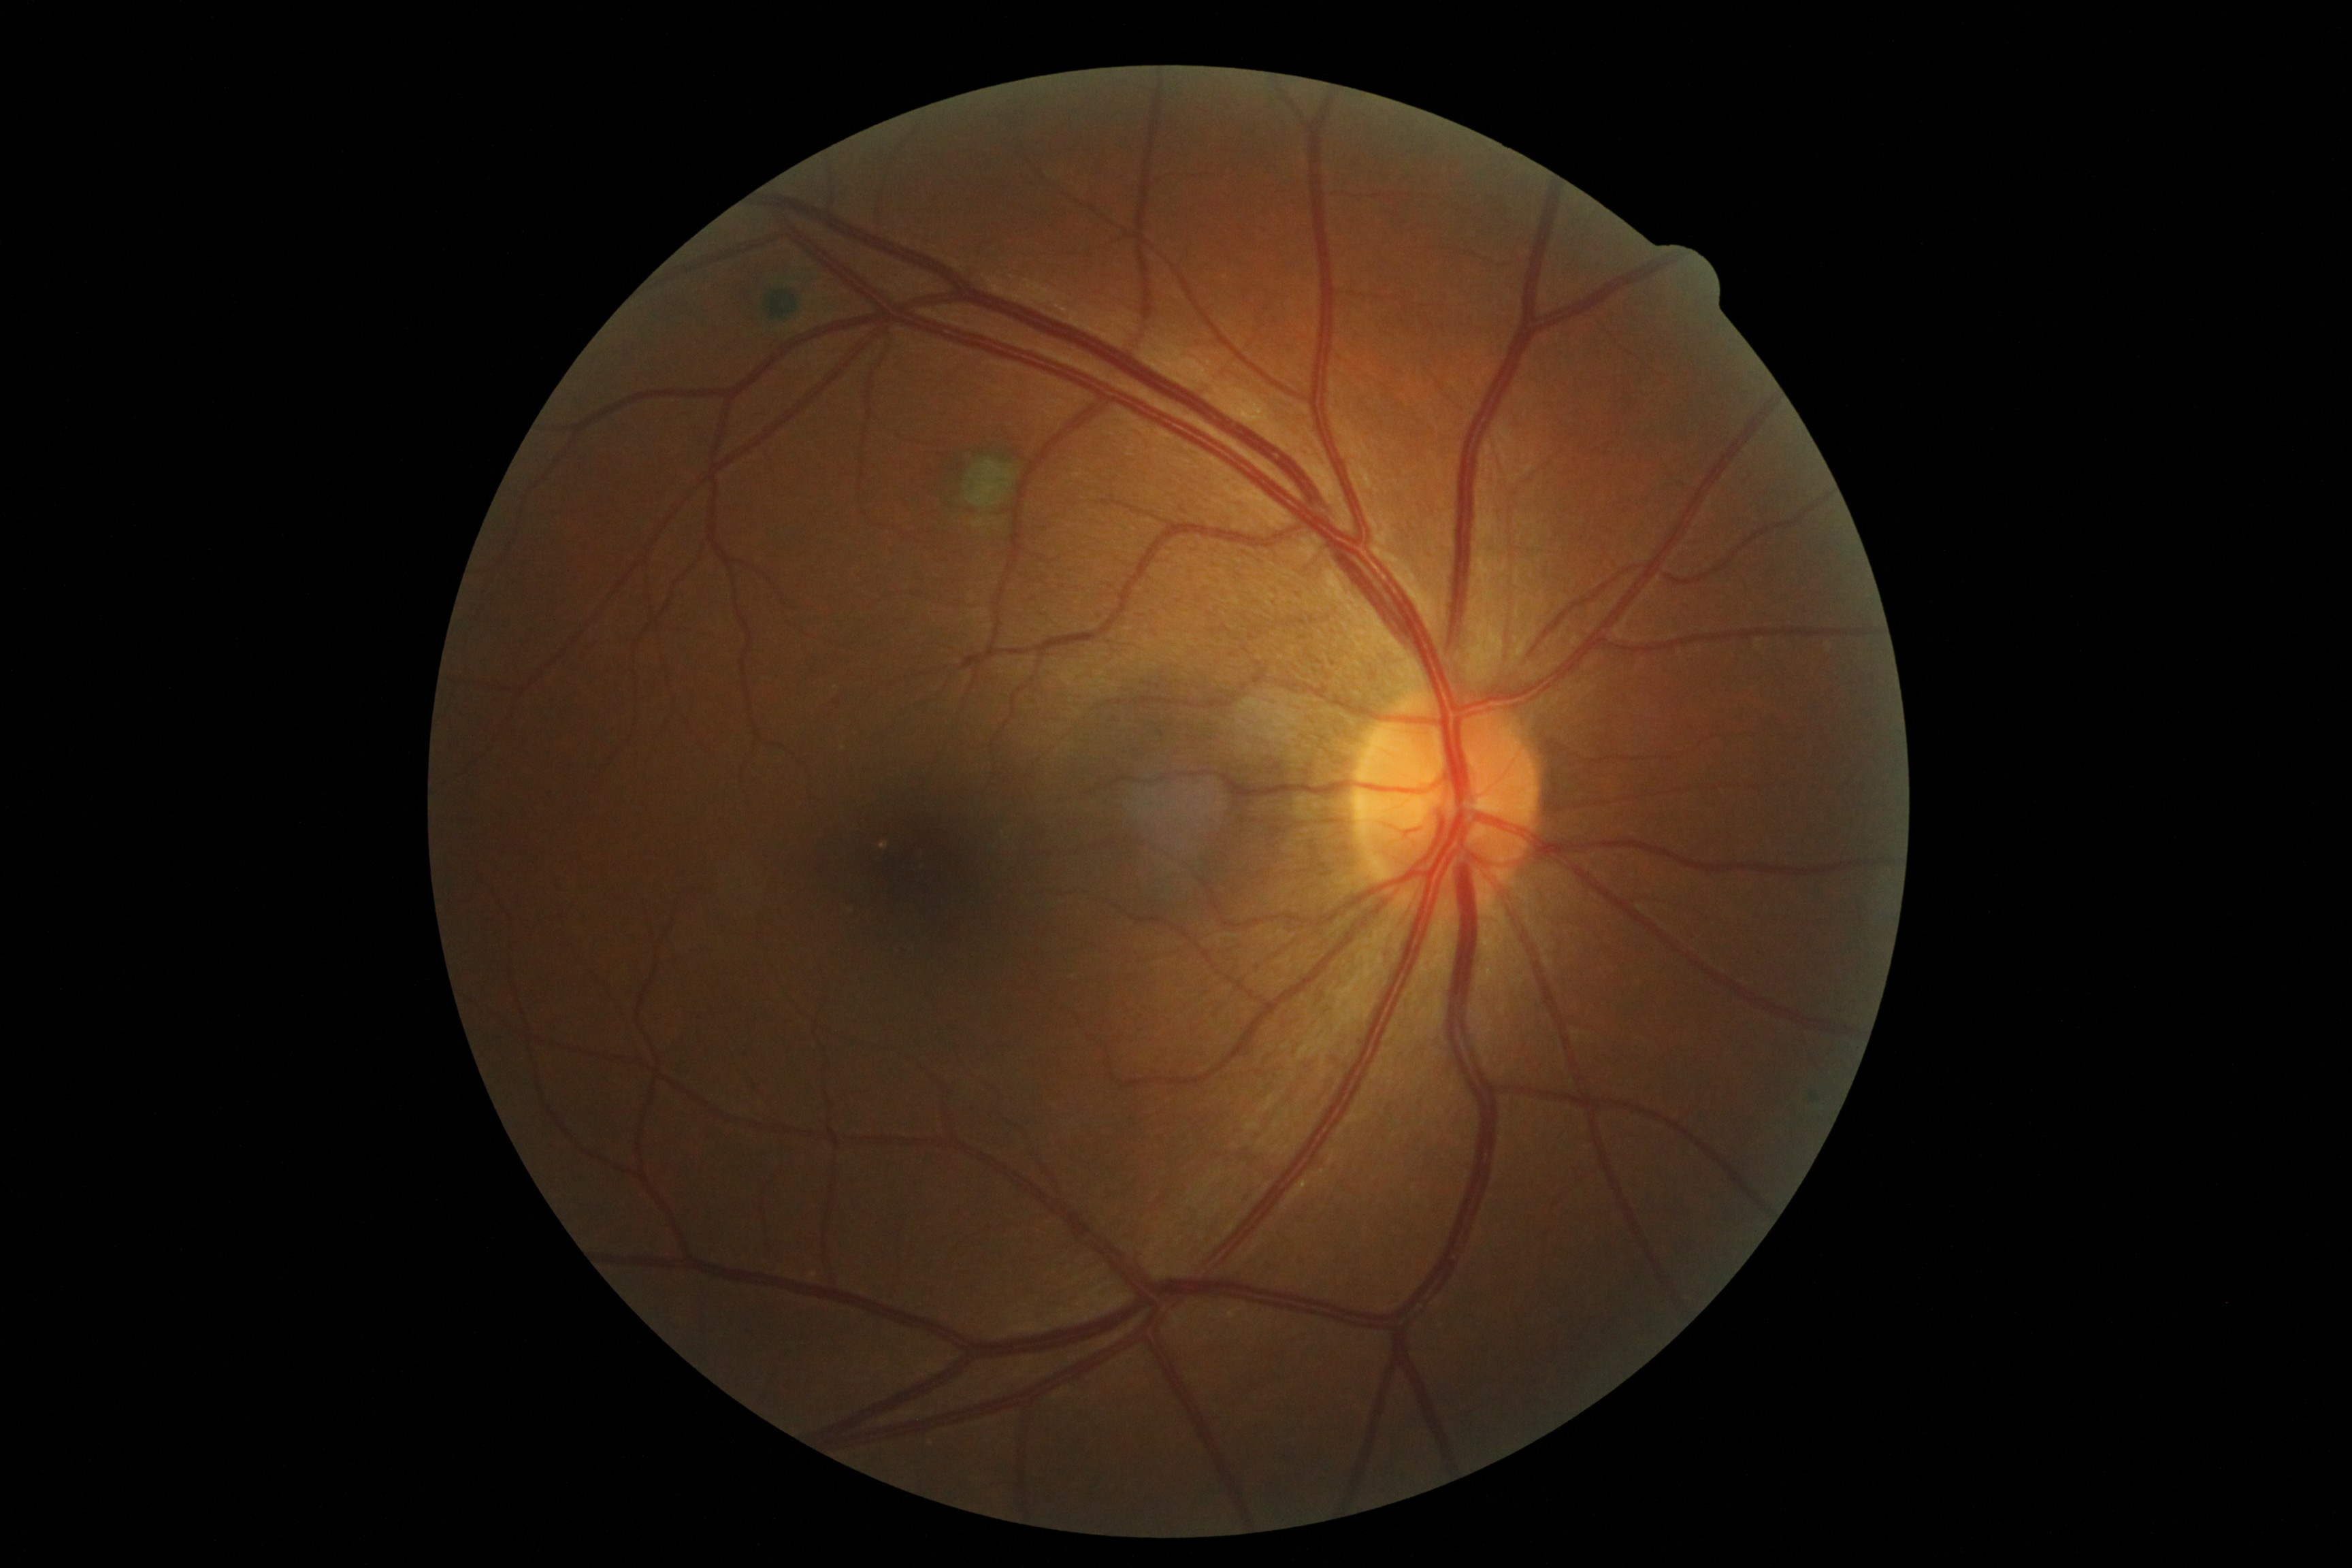 diabetic retinopathy severity=0.